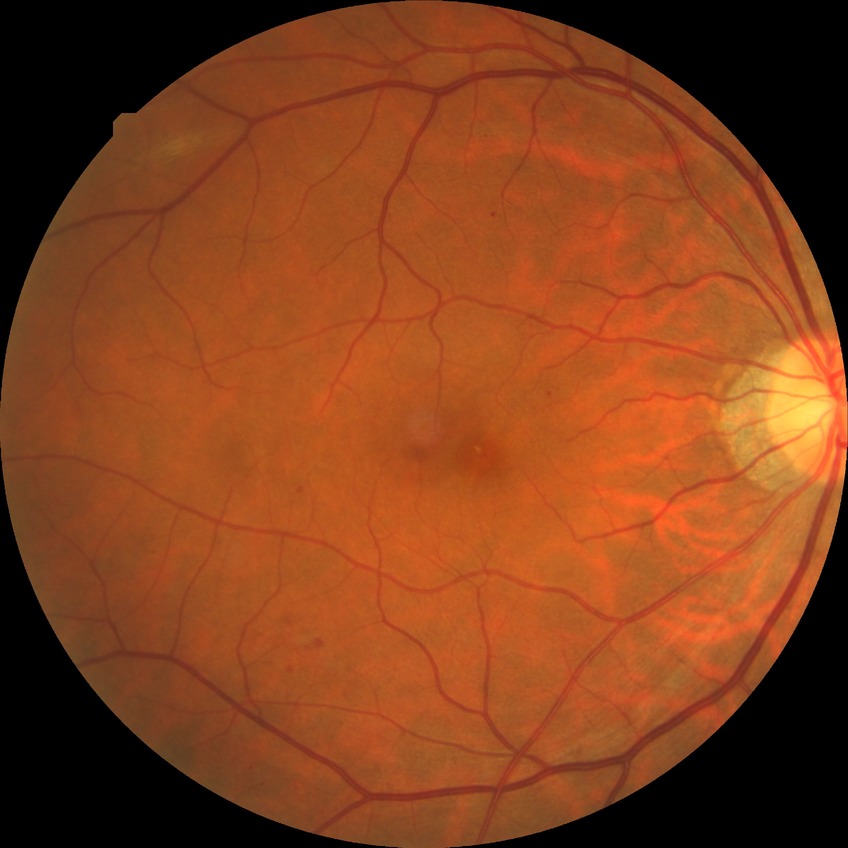 davis_grade: simple diabetic retinopathy